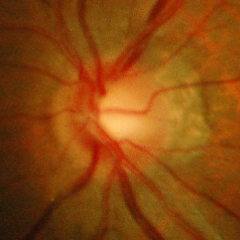
Fundus image with findings of early glaucomatous optic neuropathy.